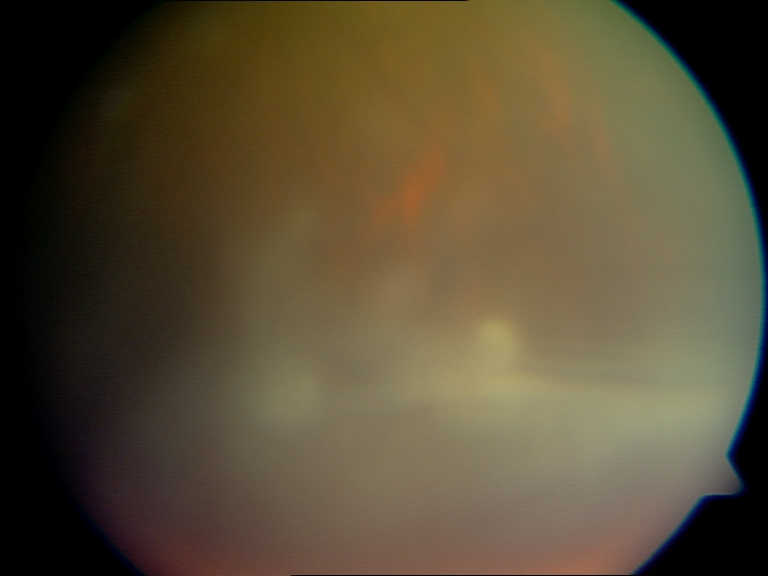 Significantly degraded image quality with obscured retinal detail. Proliferative diabetic retinopathy not identified in the visible portion.